CFP: 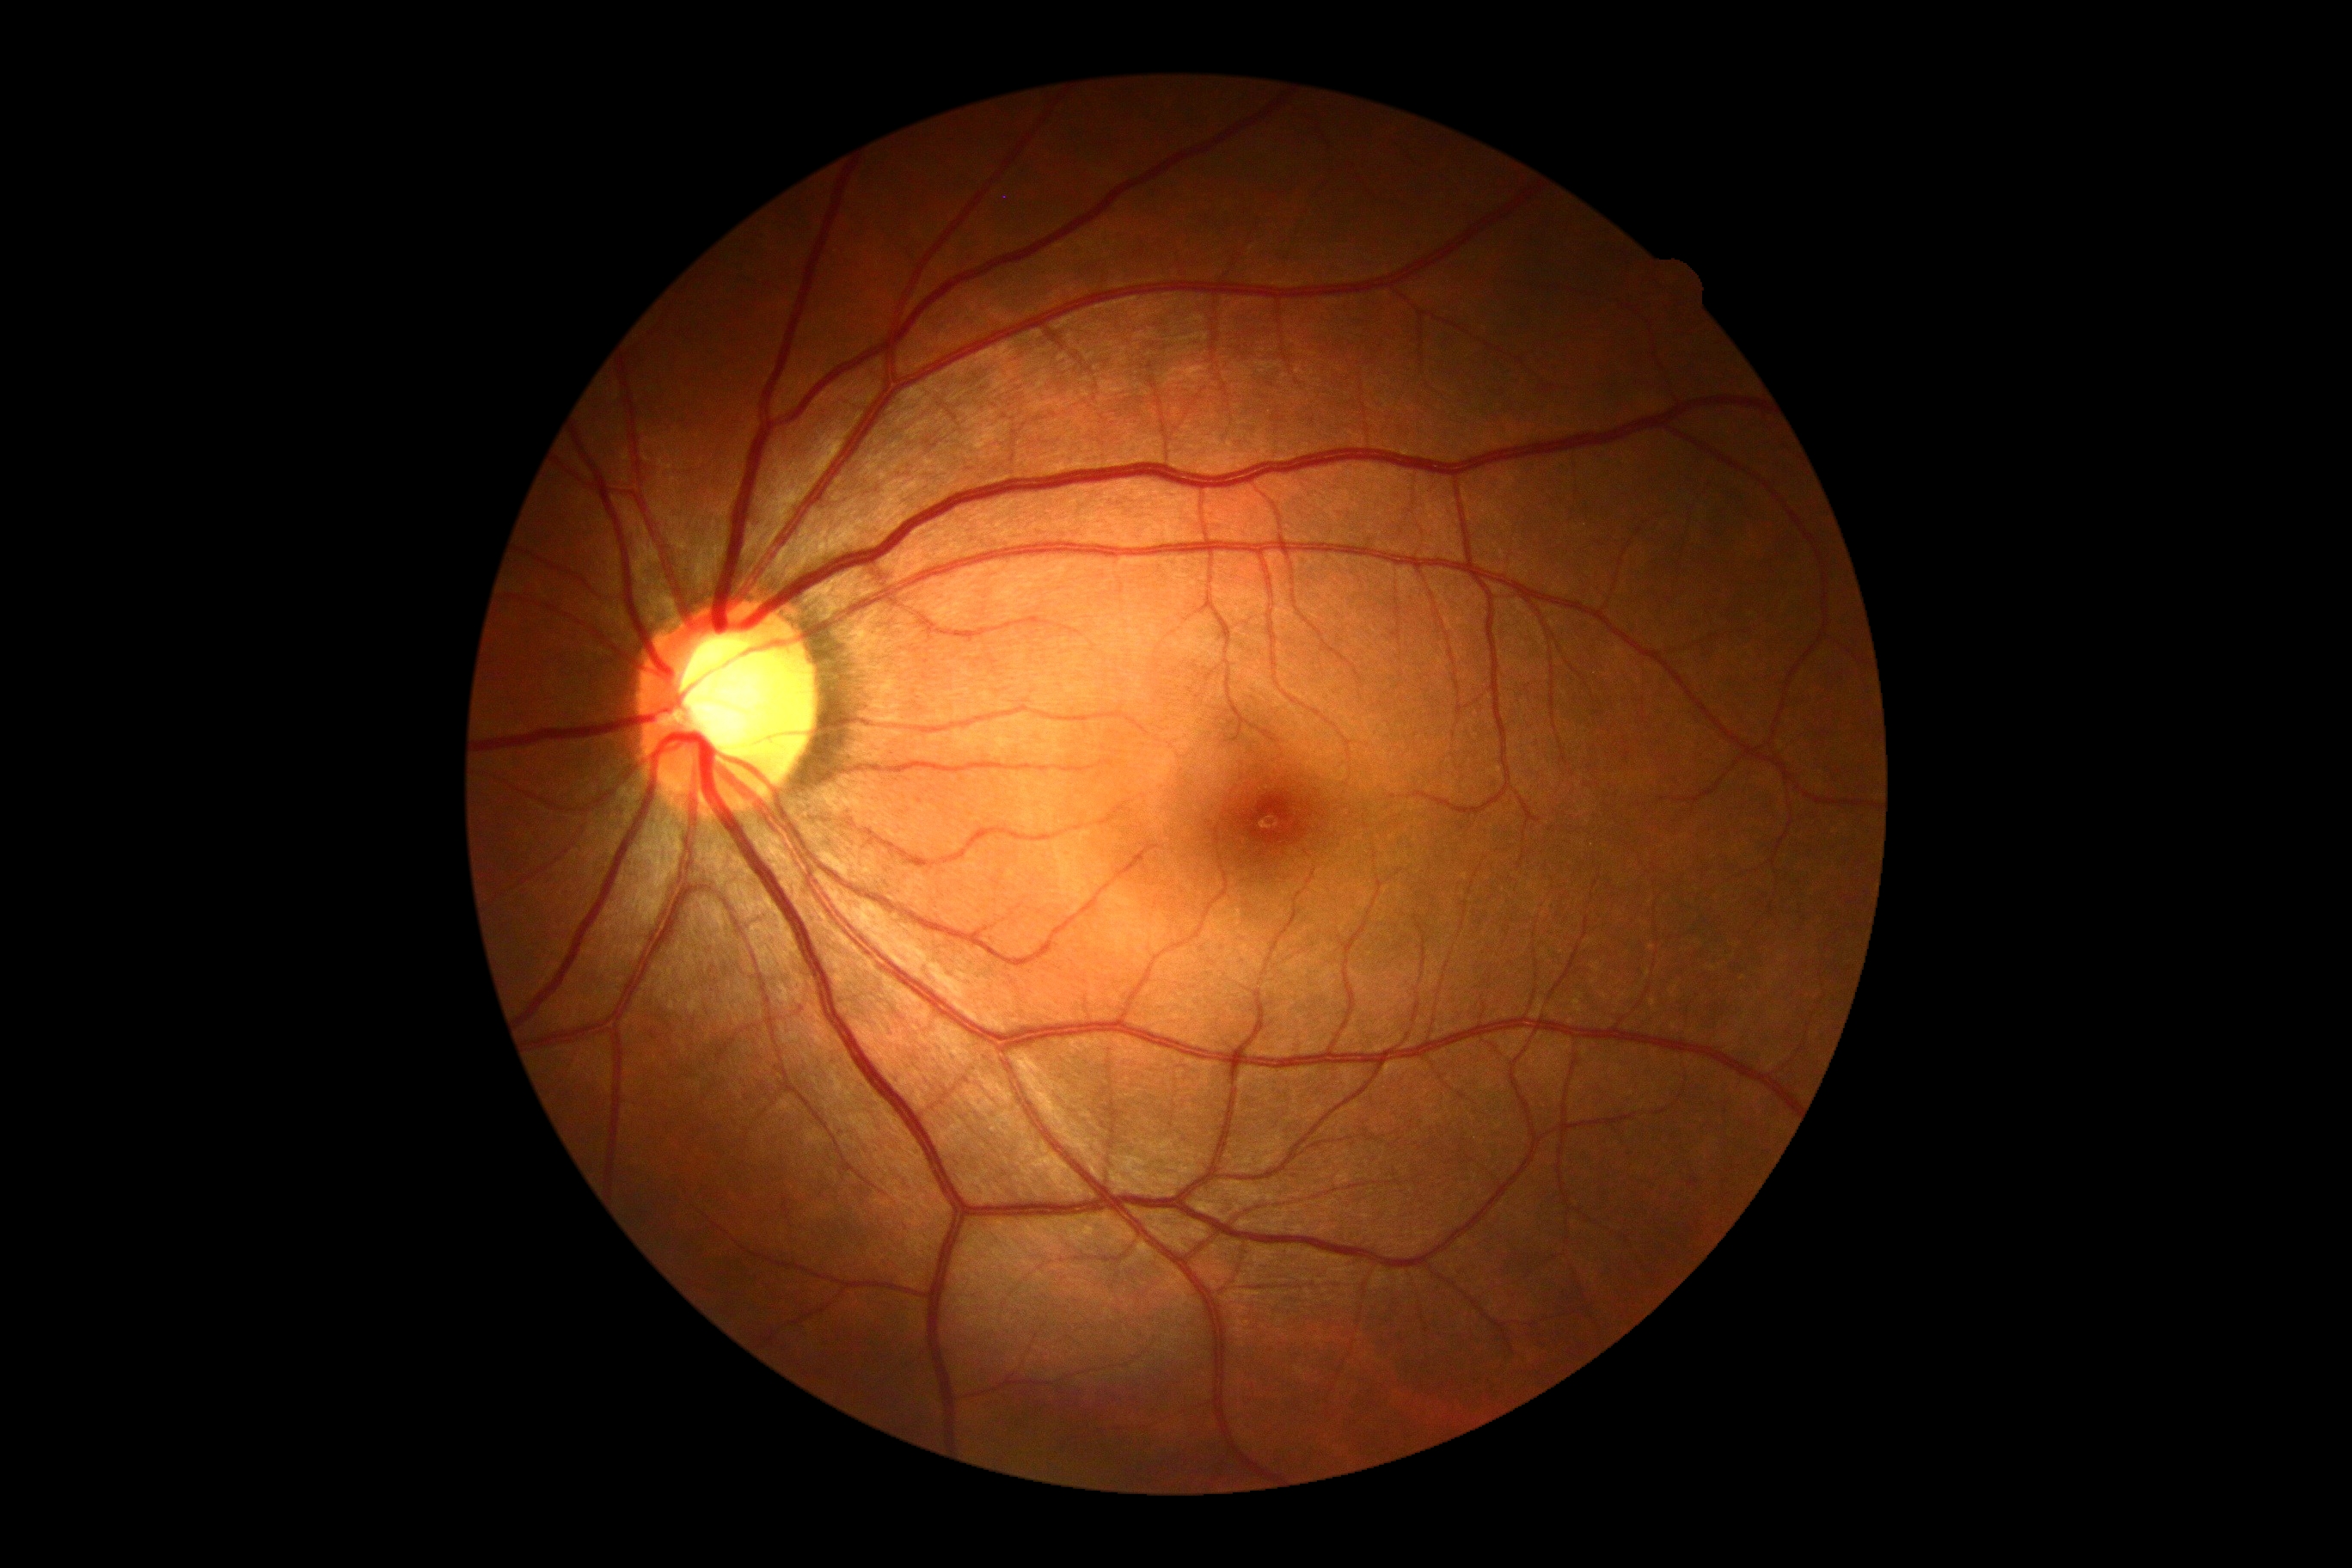 {"dr_grade": "grade 0"}